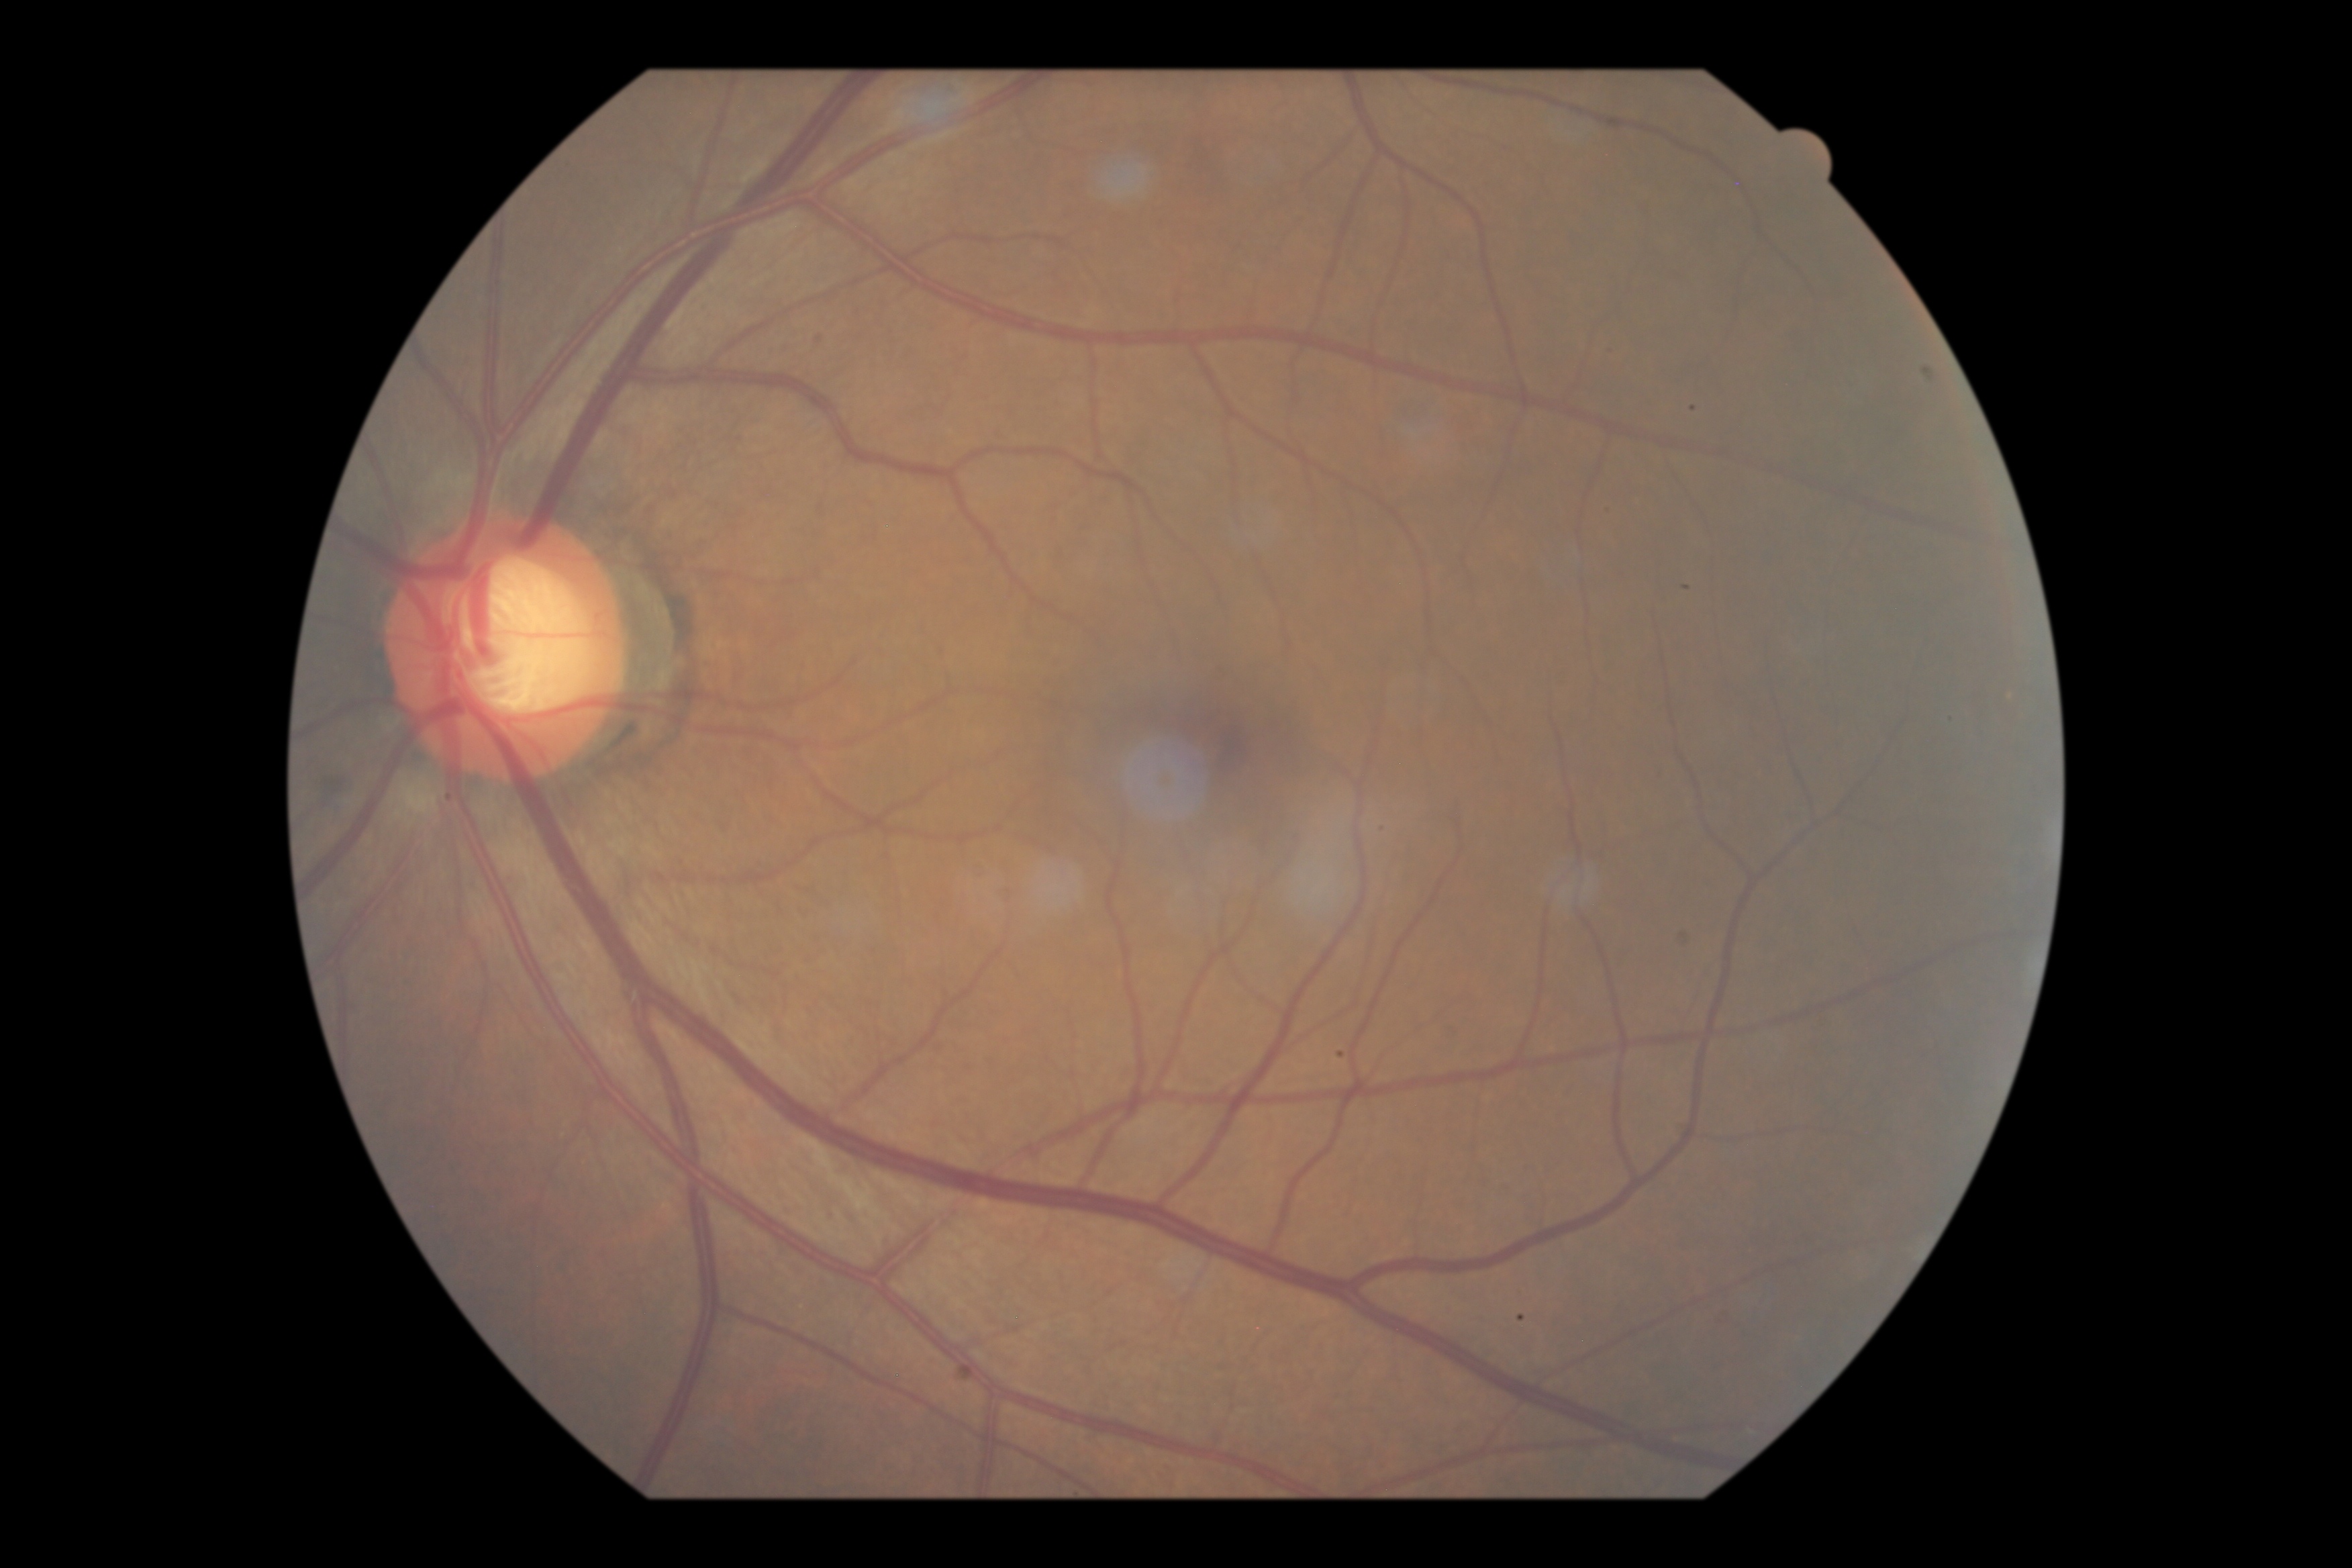
DR is grade 1 (mild NPDR). Disease class: non-proliferative diabetic retinopathy.